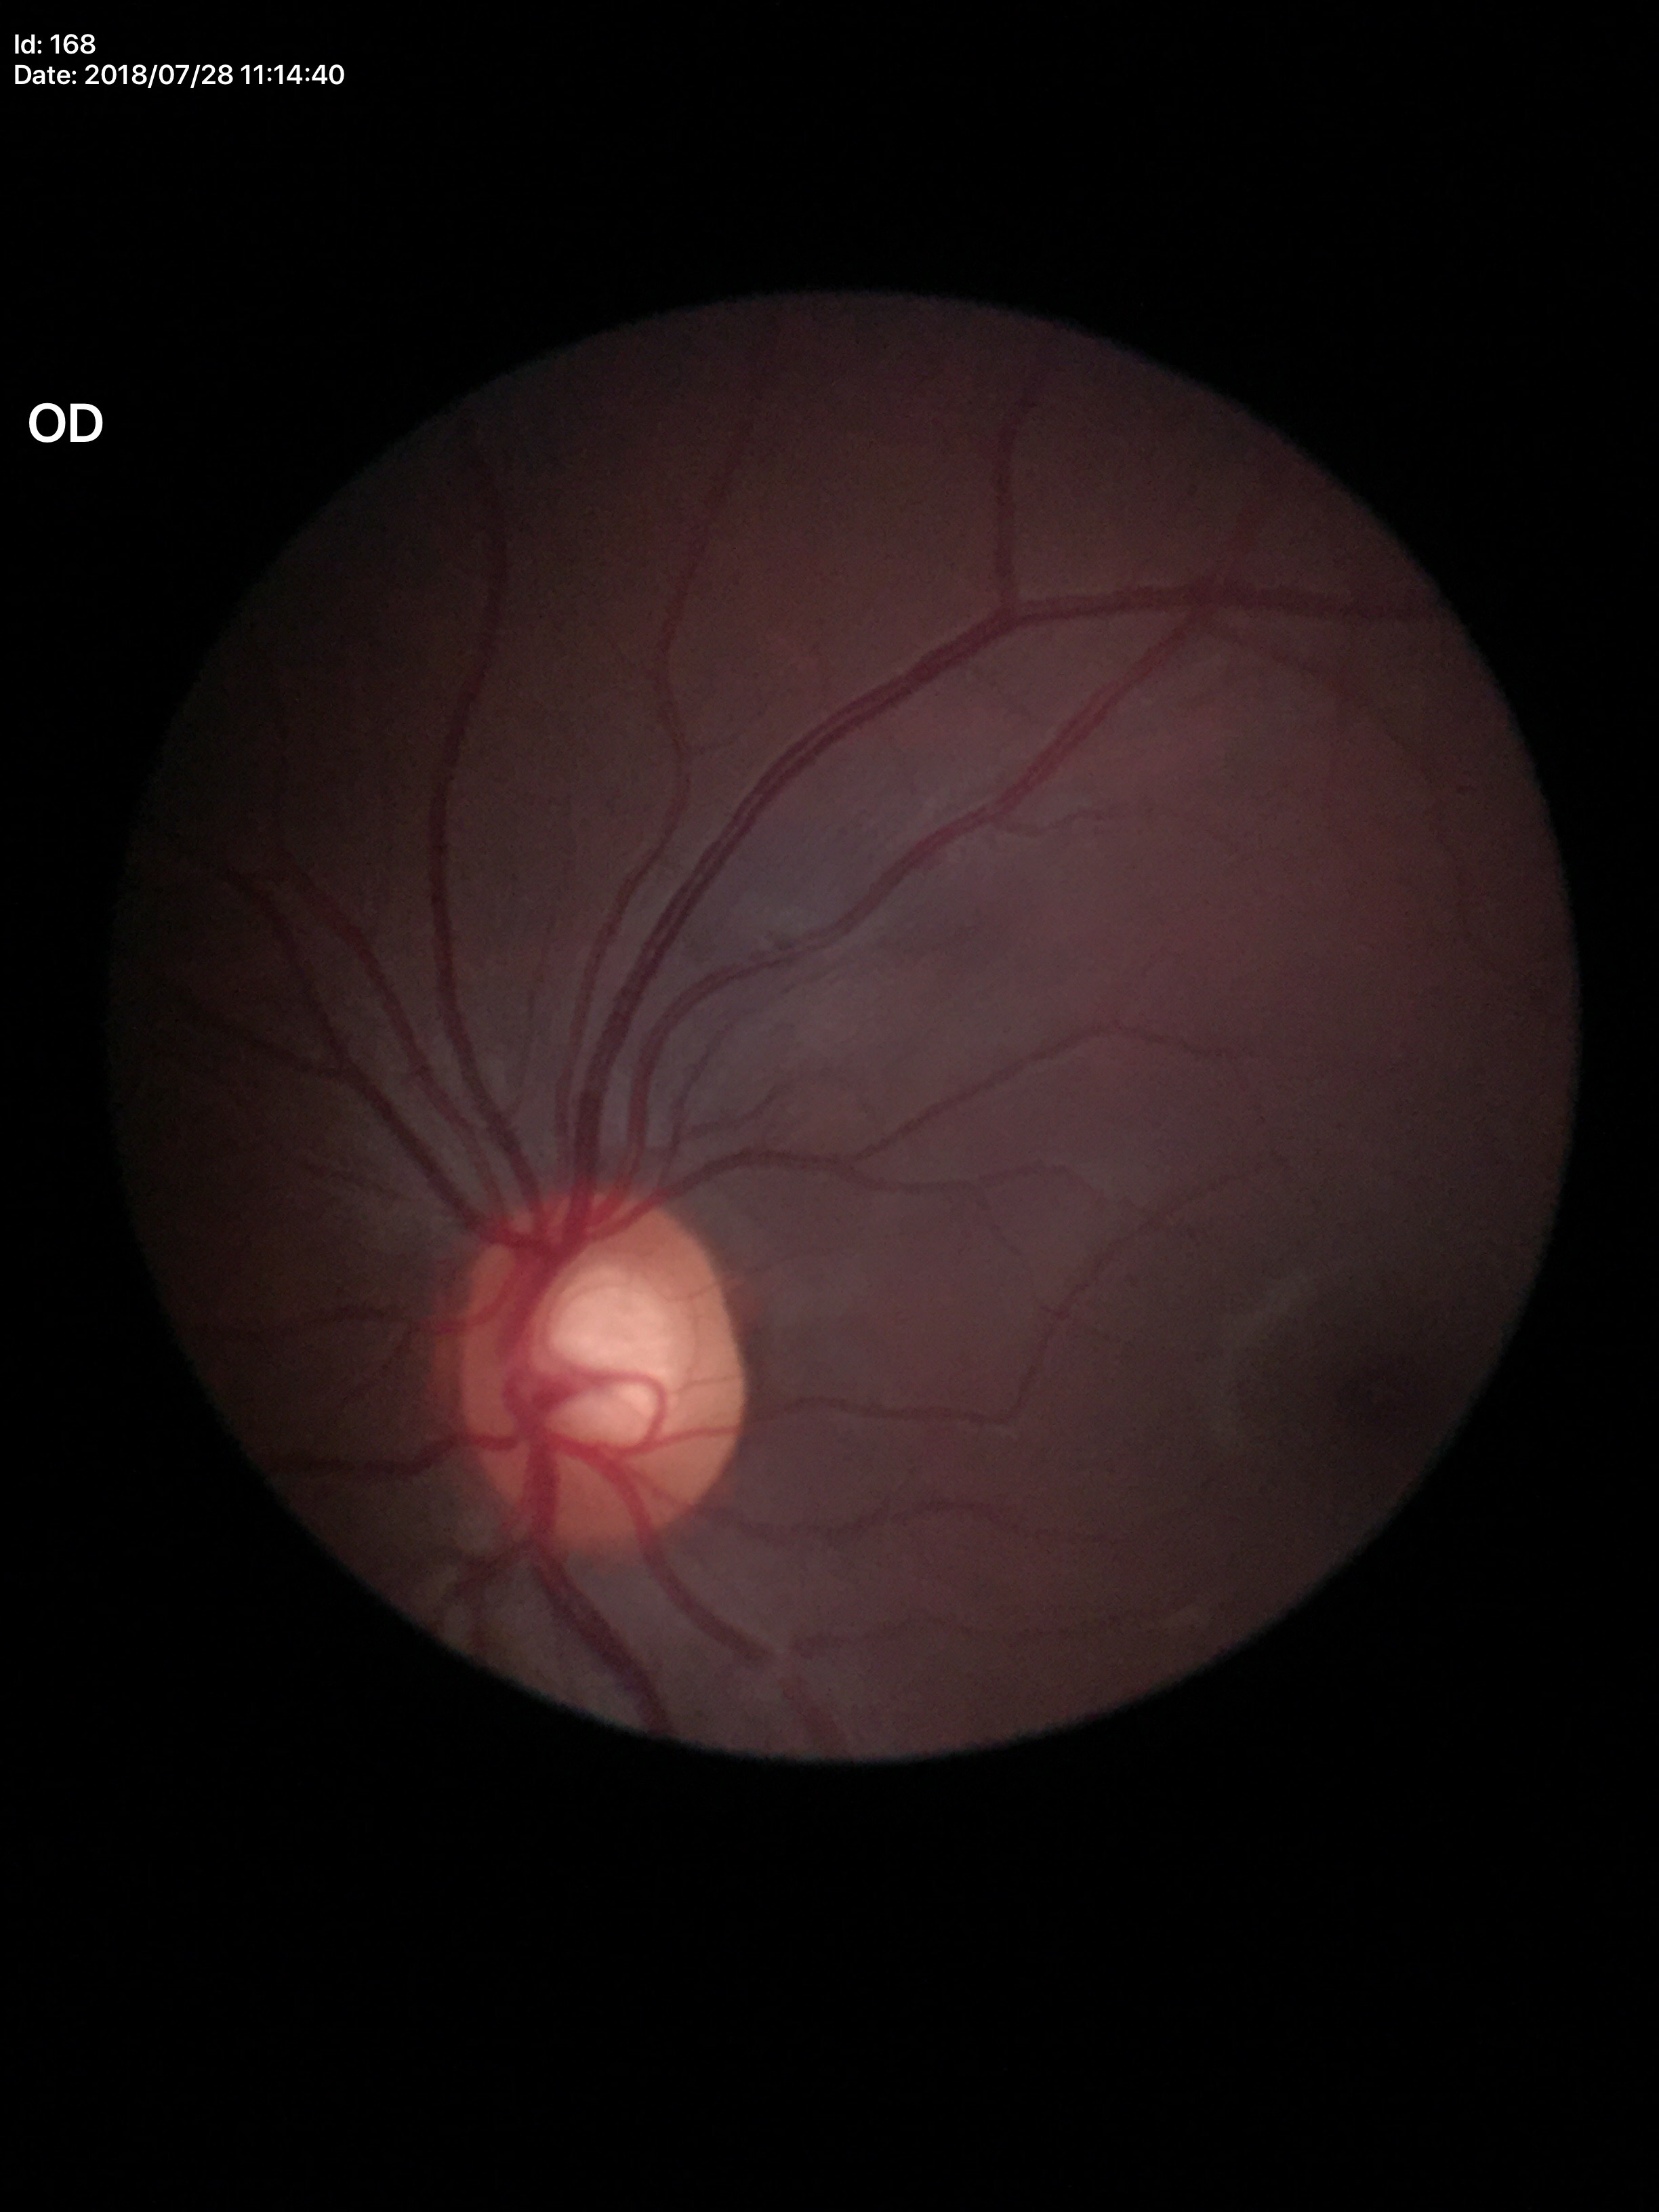

Optic disc analysis:
- Glaucoma decision — not suspect (two of five ophthalmologists flagged glaucoma suspect)
- vertical C/D ratio — 0.60
- horizontal C/D ratio — 0.61